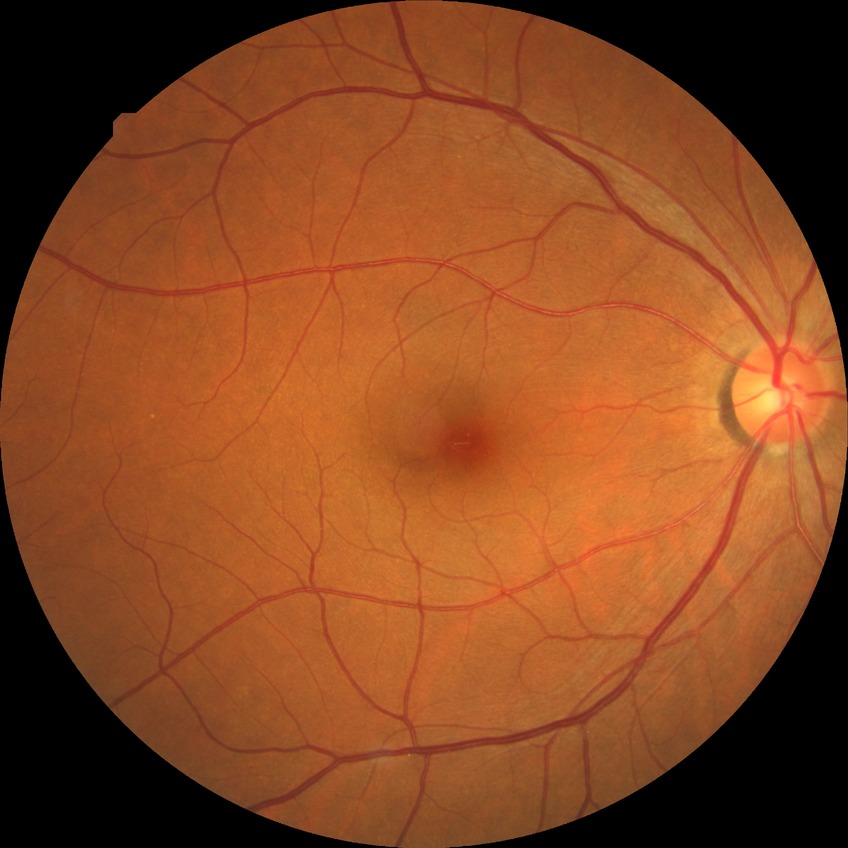 Retinopathy stage is no diabetic retinopathy.